45° field of view:
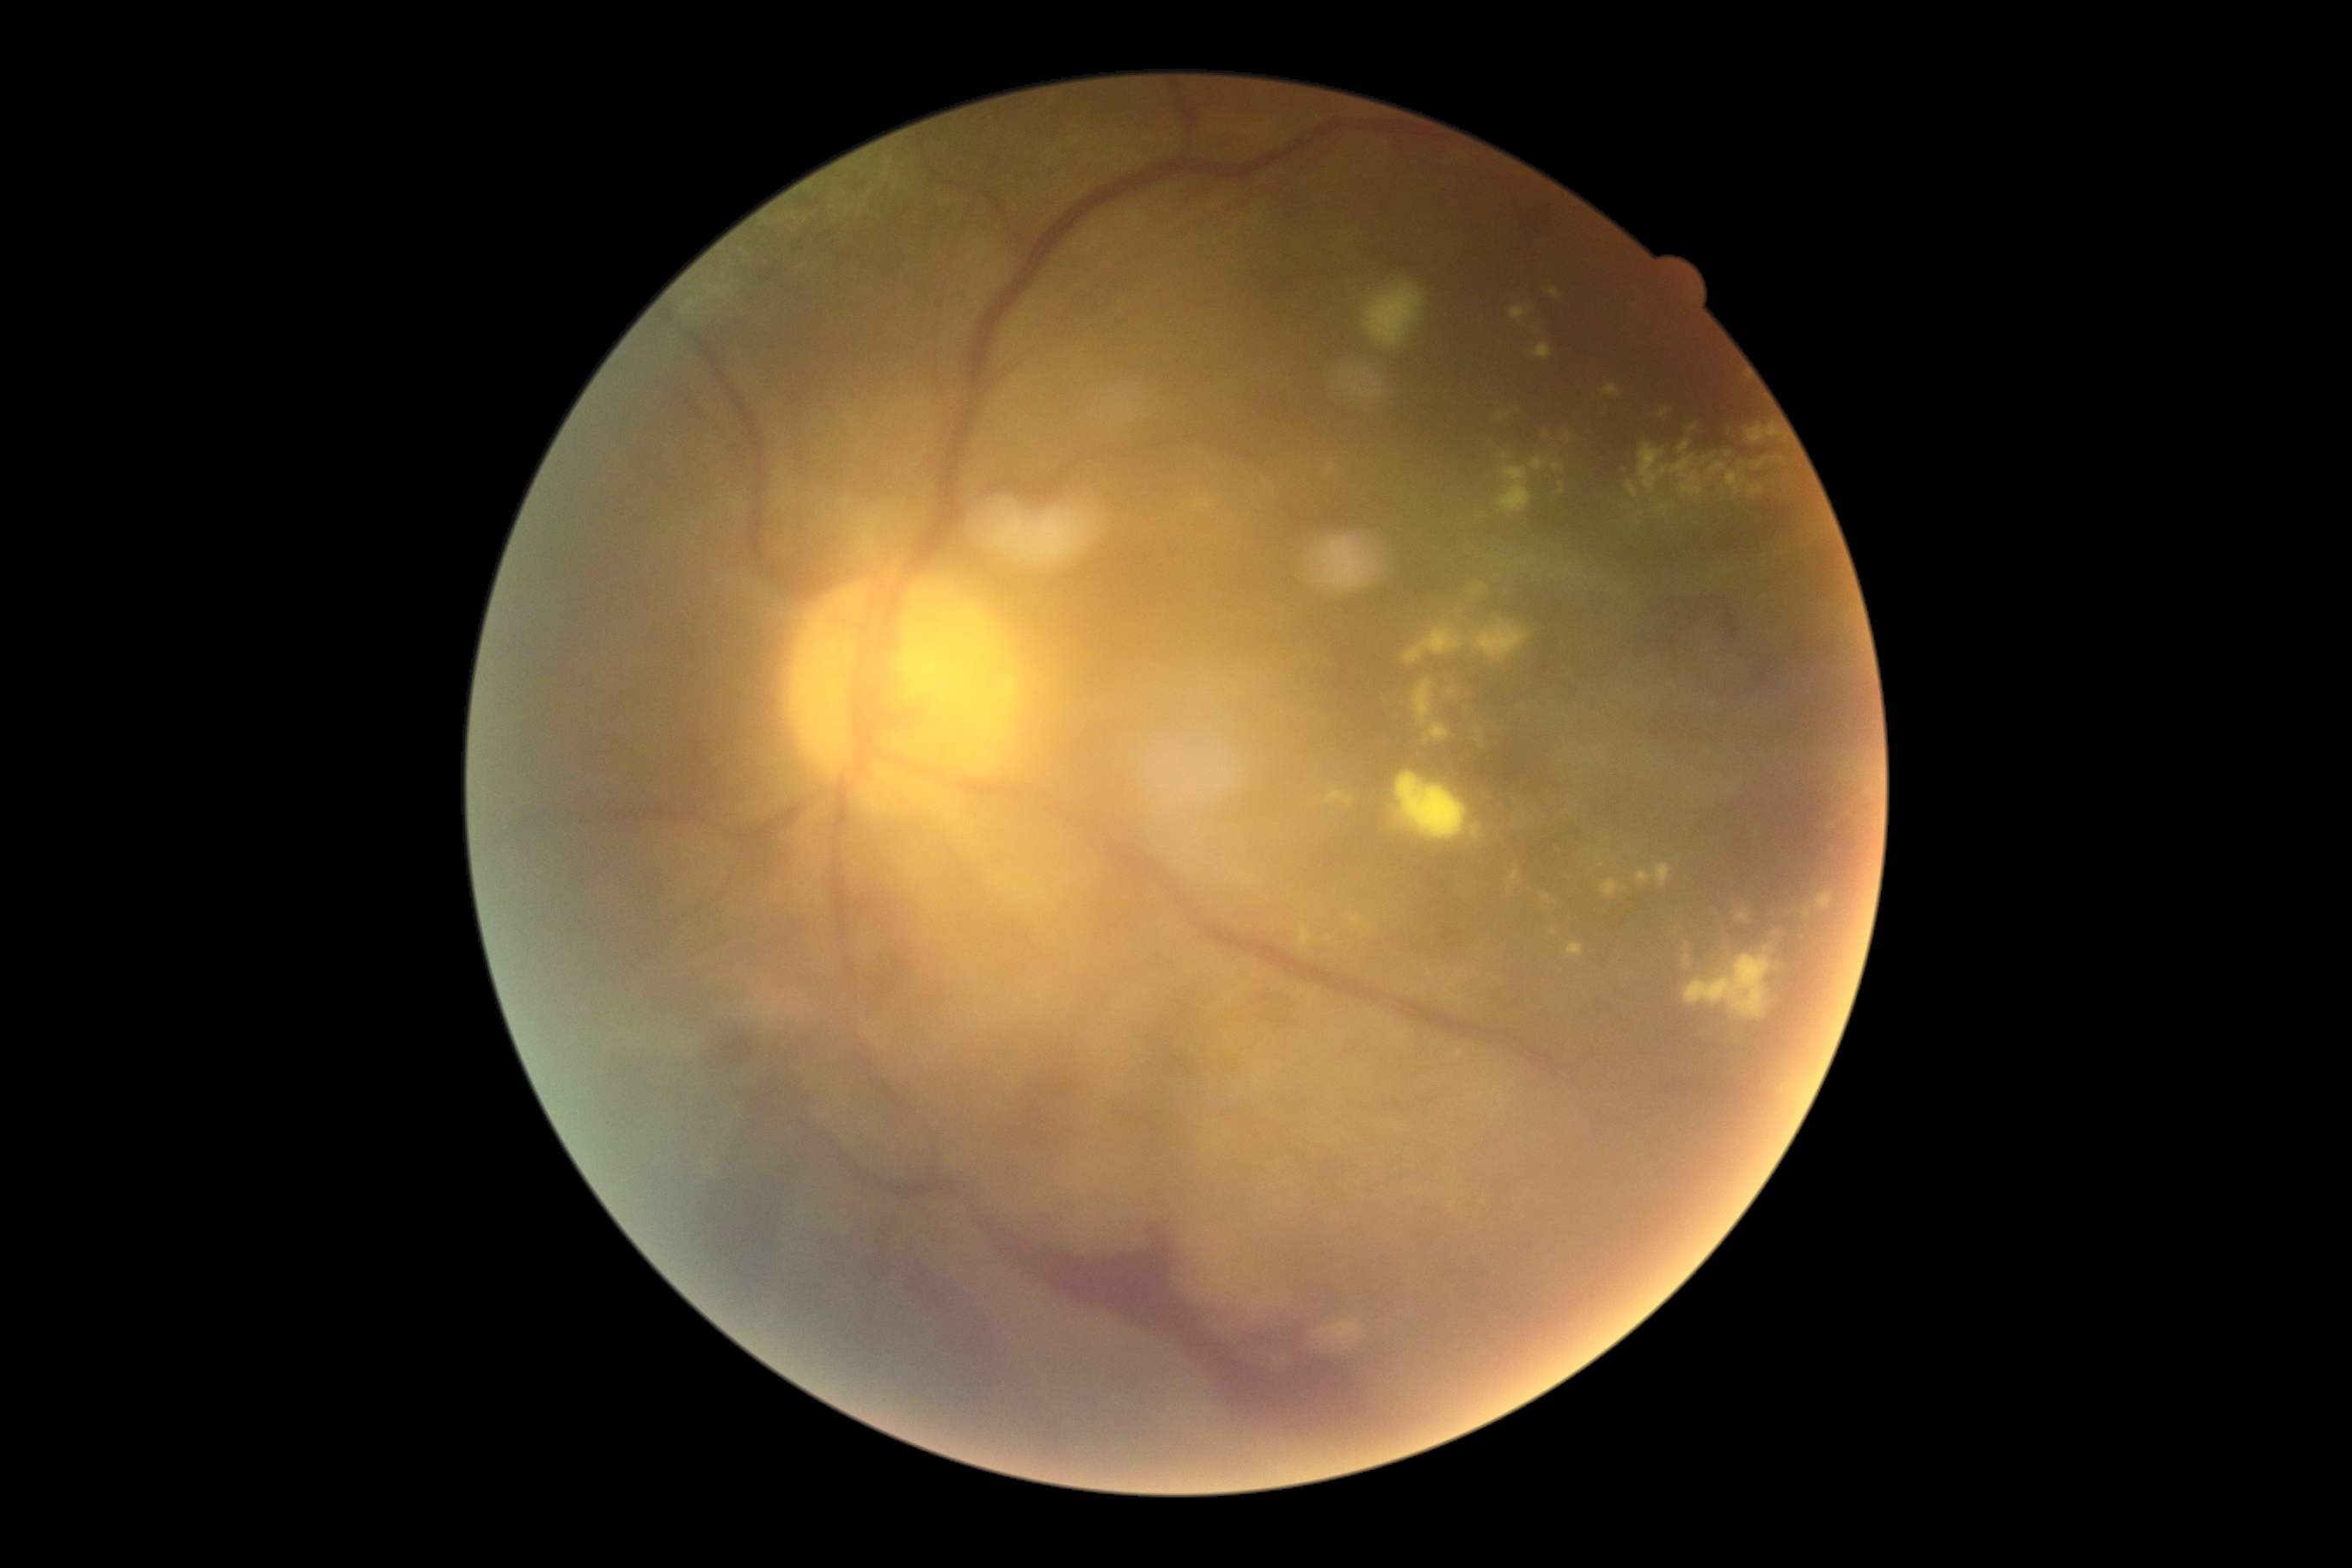 DR: PDR (grade 4); proliferative diabetic retinopathy
Representative lesions:
EXs (continued): l=1684, t=955, r=1689, b=965; l=1710, t=463, r=1727, b=477; l=1639, t=444, r=1705, b=496; l=1476, t=730, r=1486, b=749; l=1497, t=467, r=1531, b=515; l=1533, t=460, r=1547, b=472; l=1452, t=996, r=1461, b=1001; l=1509, t=305, r=1533, b=326; l=1756, t=462, r=1765, b=470; l=1553, t=463, r=1565, b=472; l=1471, t=826, r=1481, b=838; l=1529, t=343, r=1552, b=360
Smaller EXs around (1568; 572); (1777; 933); (1459; 1053)